1504x1000: 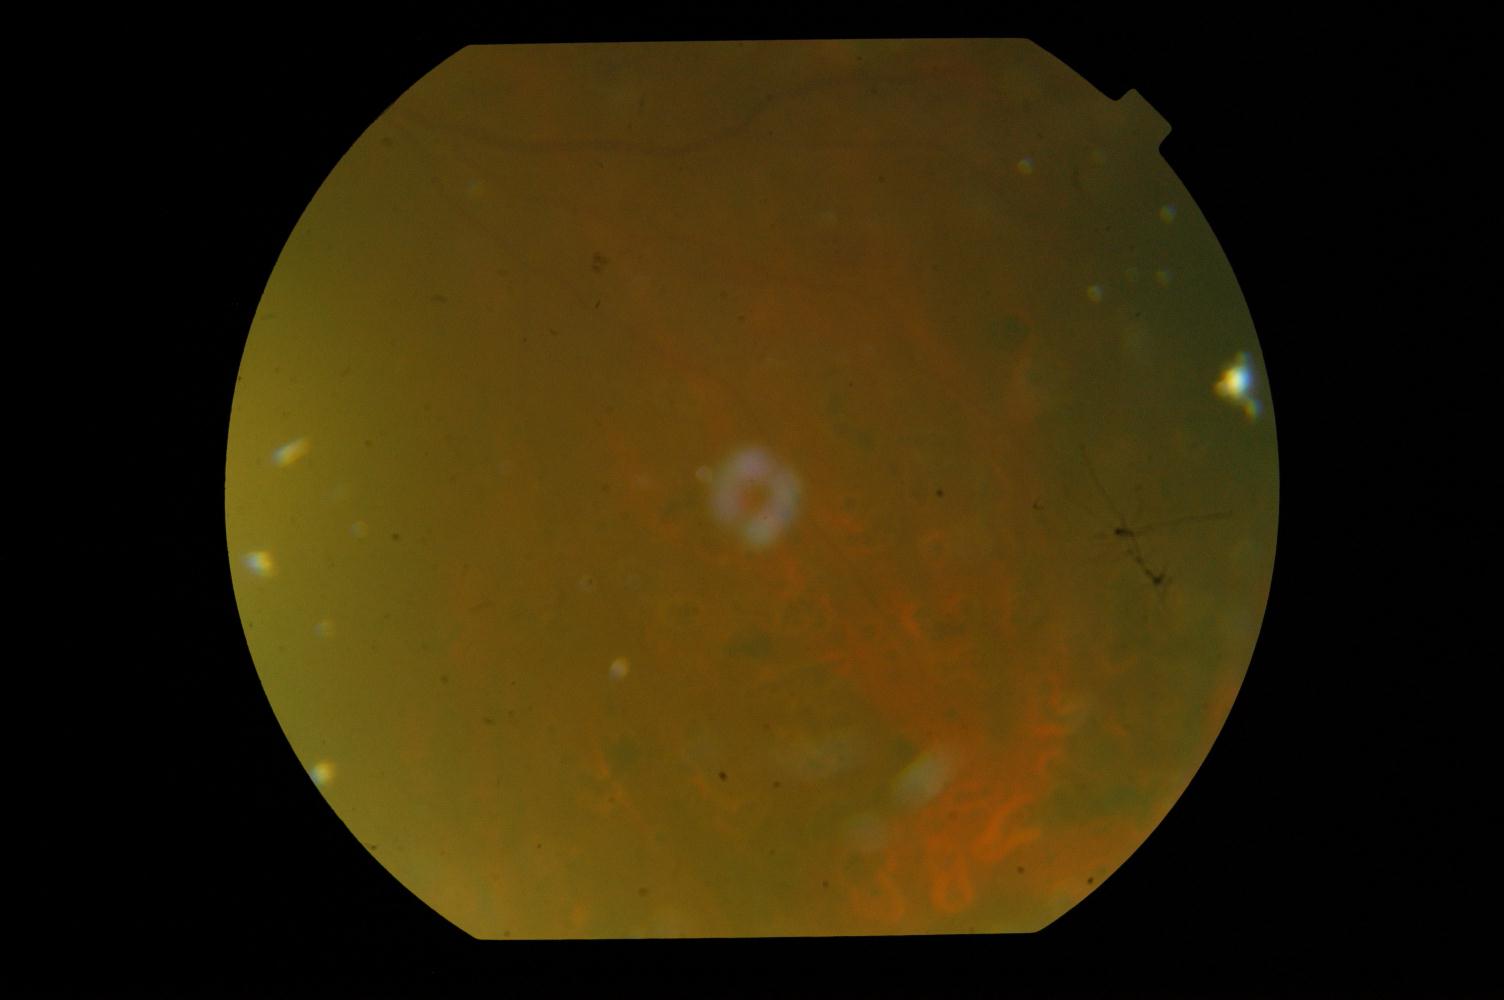
Demonstrates DR (diabetic retinopathy).